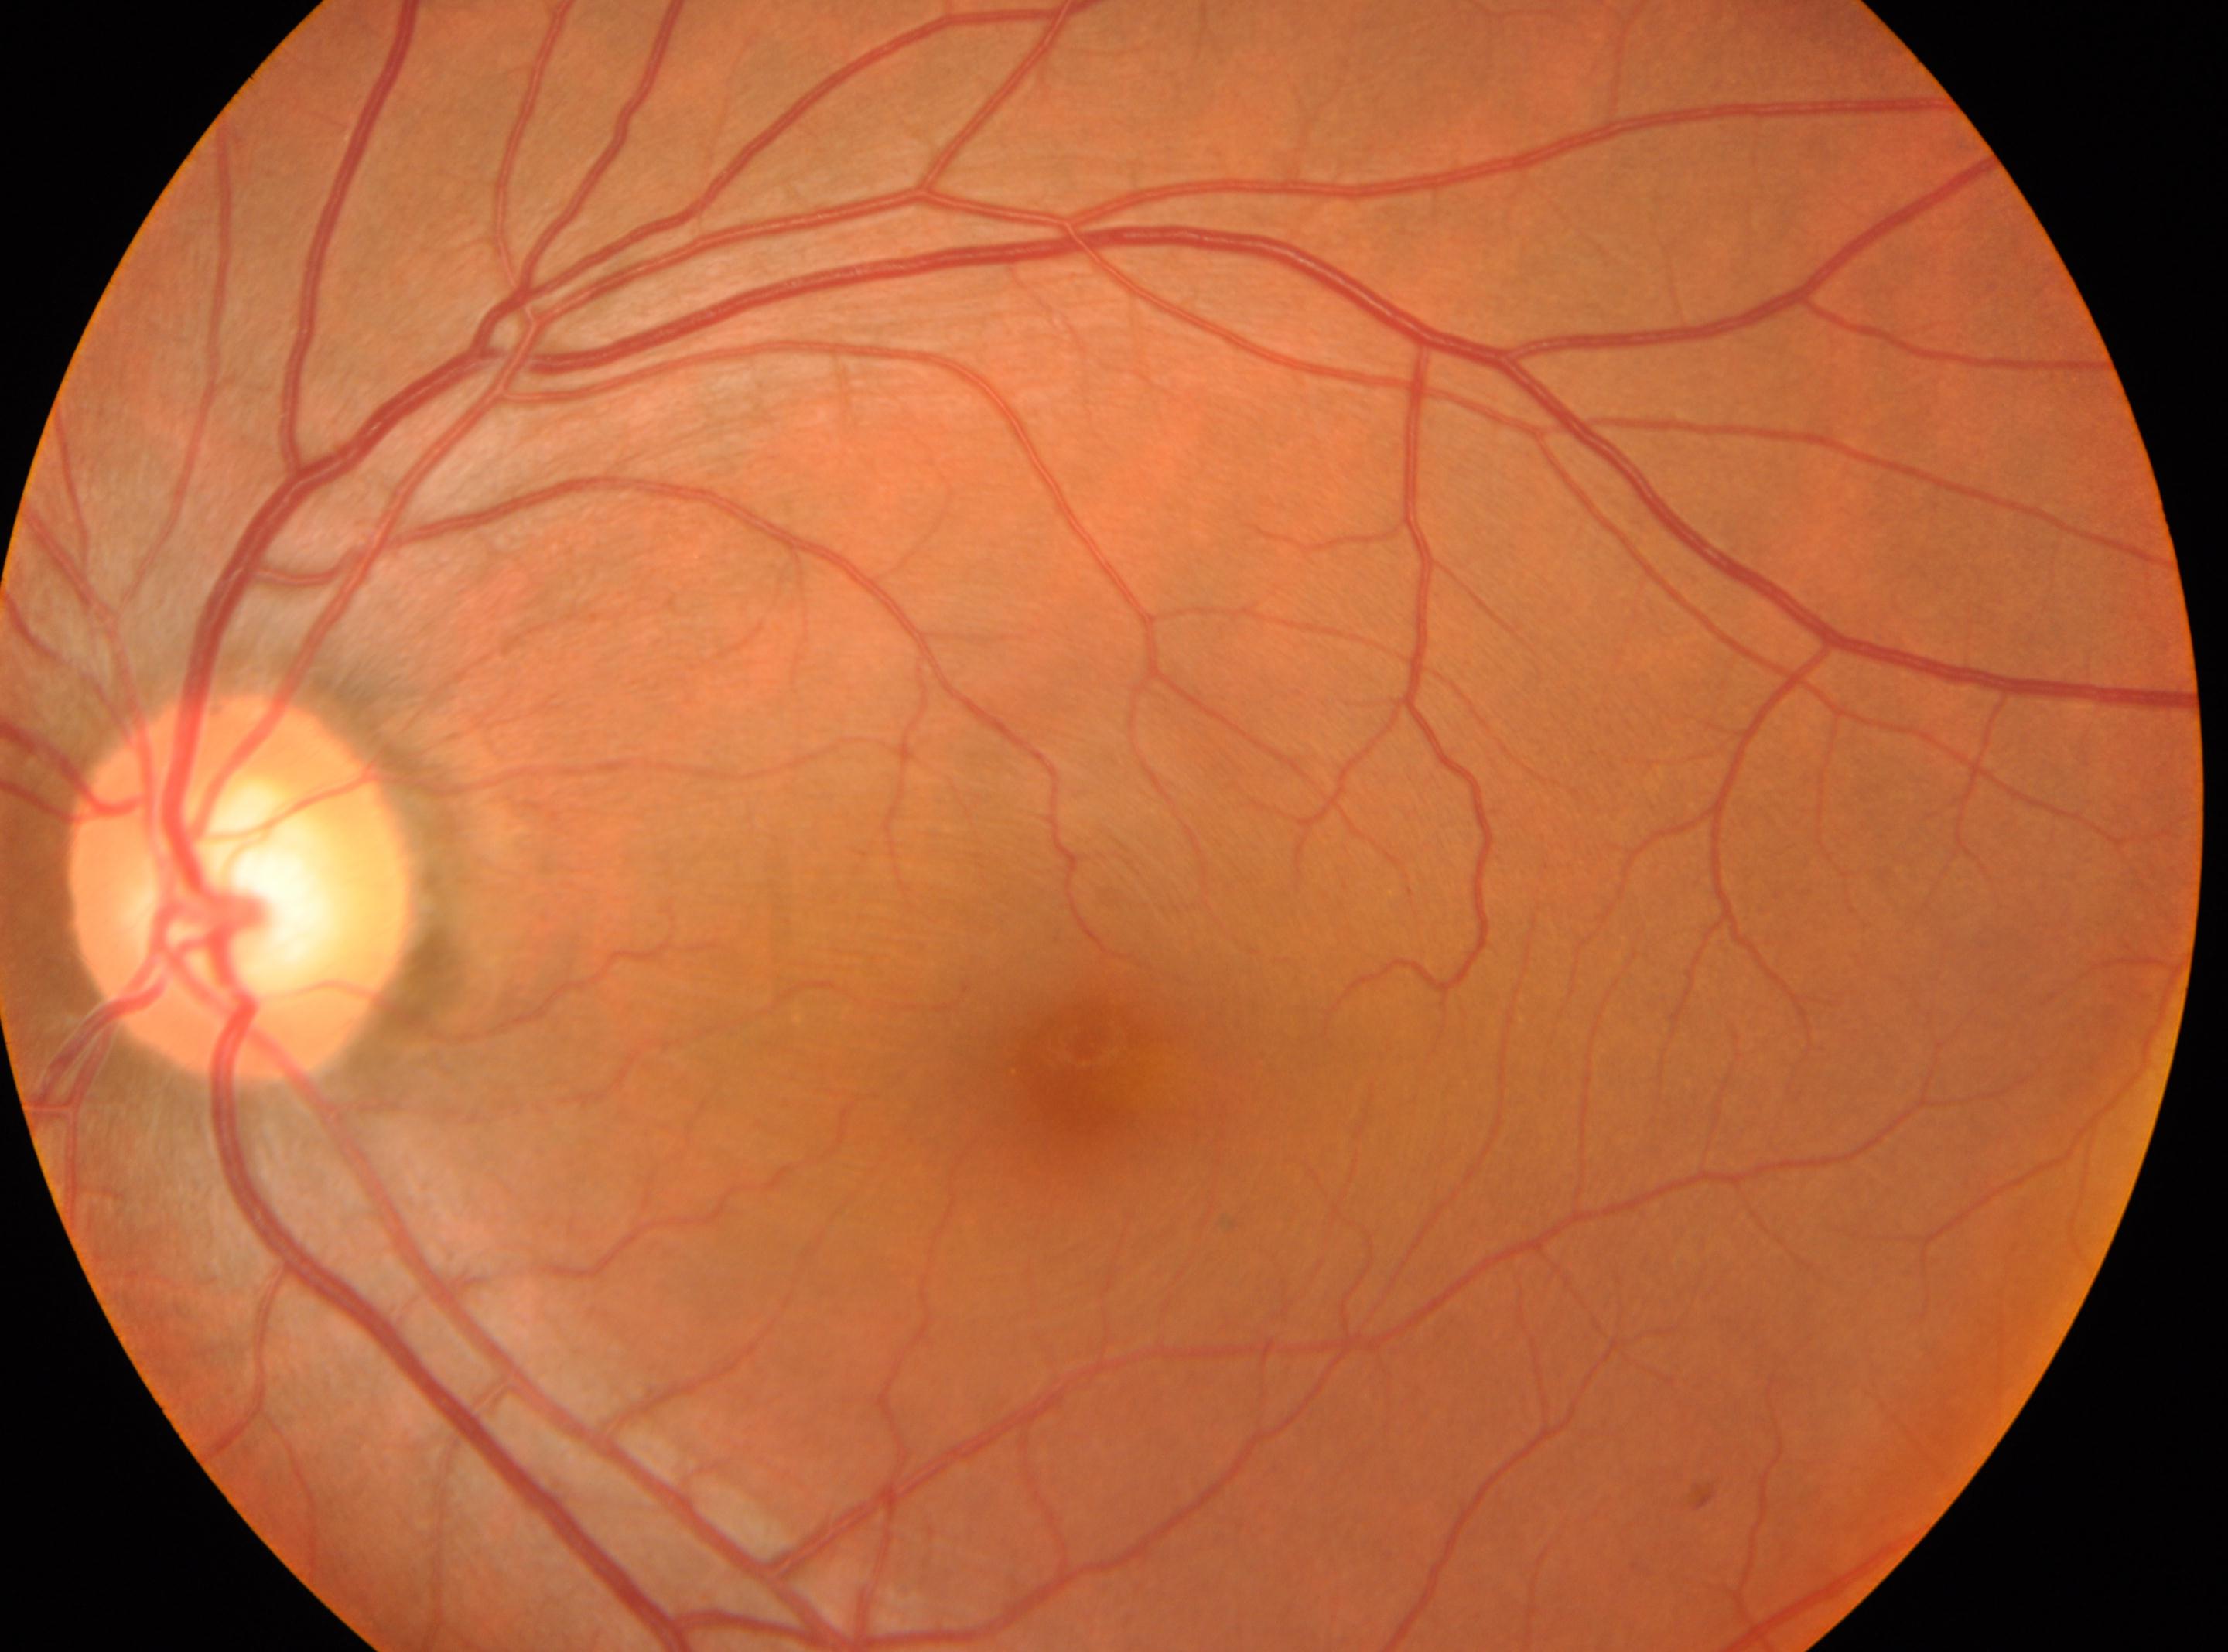
retinopathy grade = 0 (no apparent retinopathy); optic nerve head = 242, 885; laterality = left; foveal center = 1091, 1061.